Image size 412x310, fundus photo — 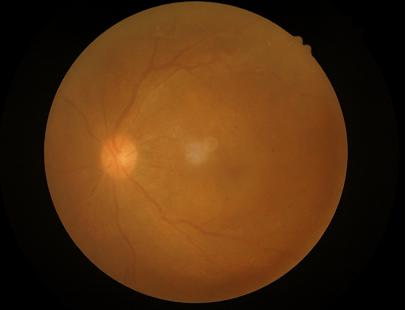
Contrast: poor dynamic range; Overall image quality: inadequate for clinical interpretation; Sharpness: noticeable blur in the optic disc, vessels, or background; Illumination: uniform, no color cast.